45° field of view. CFP. 2352x1568px — 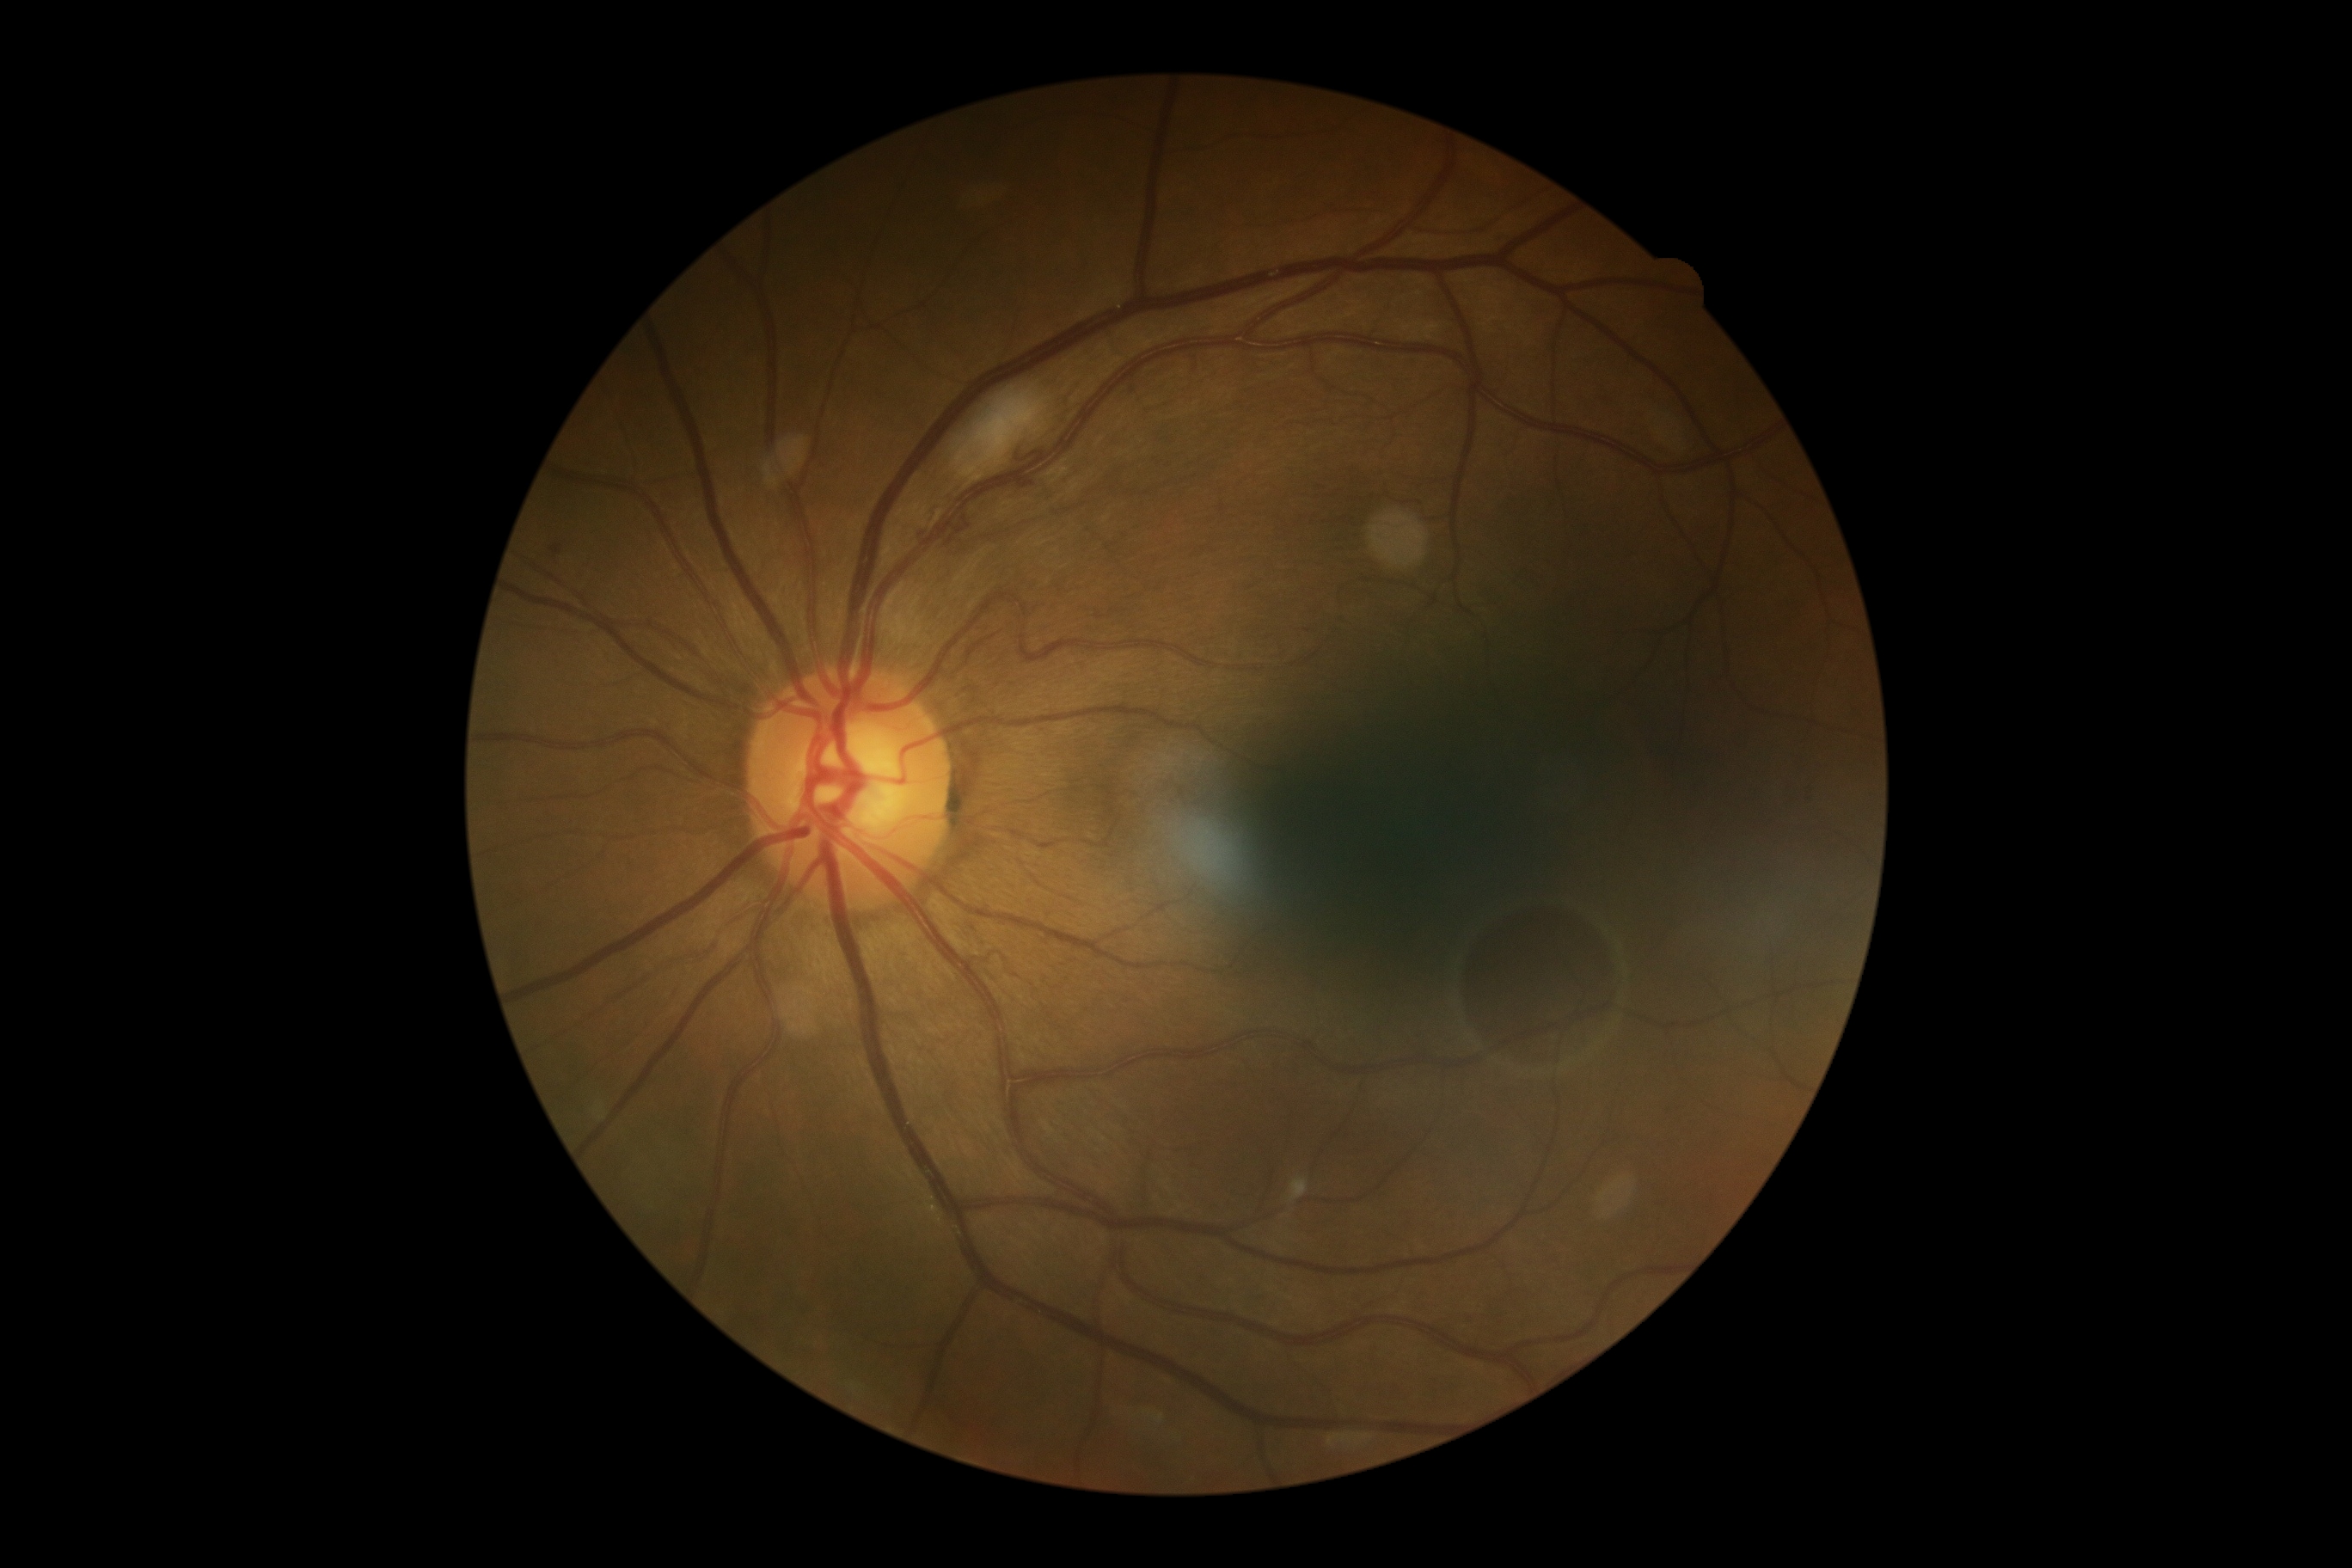 – DR class: non-proliferative diabetic retinopathy
– retinopathy: 2/4